Image size 2352x1568; color fundus image; 45-degree field of view: 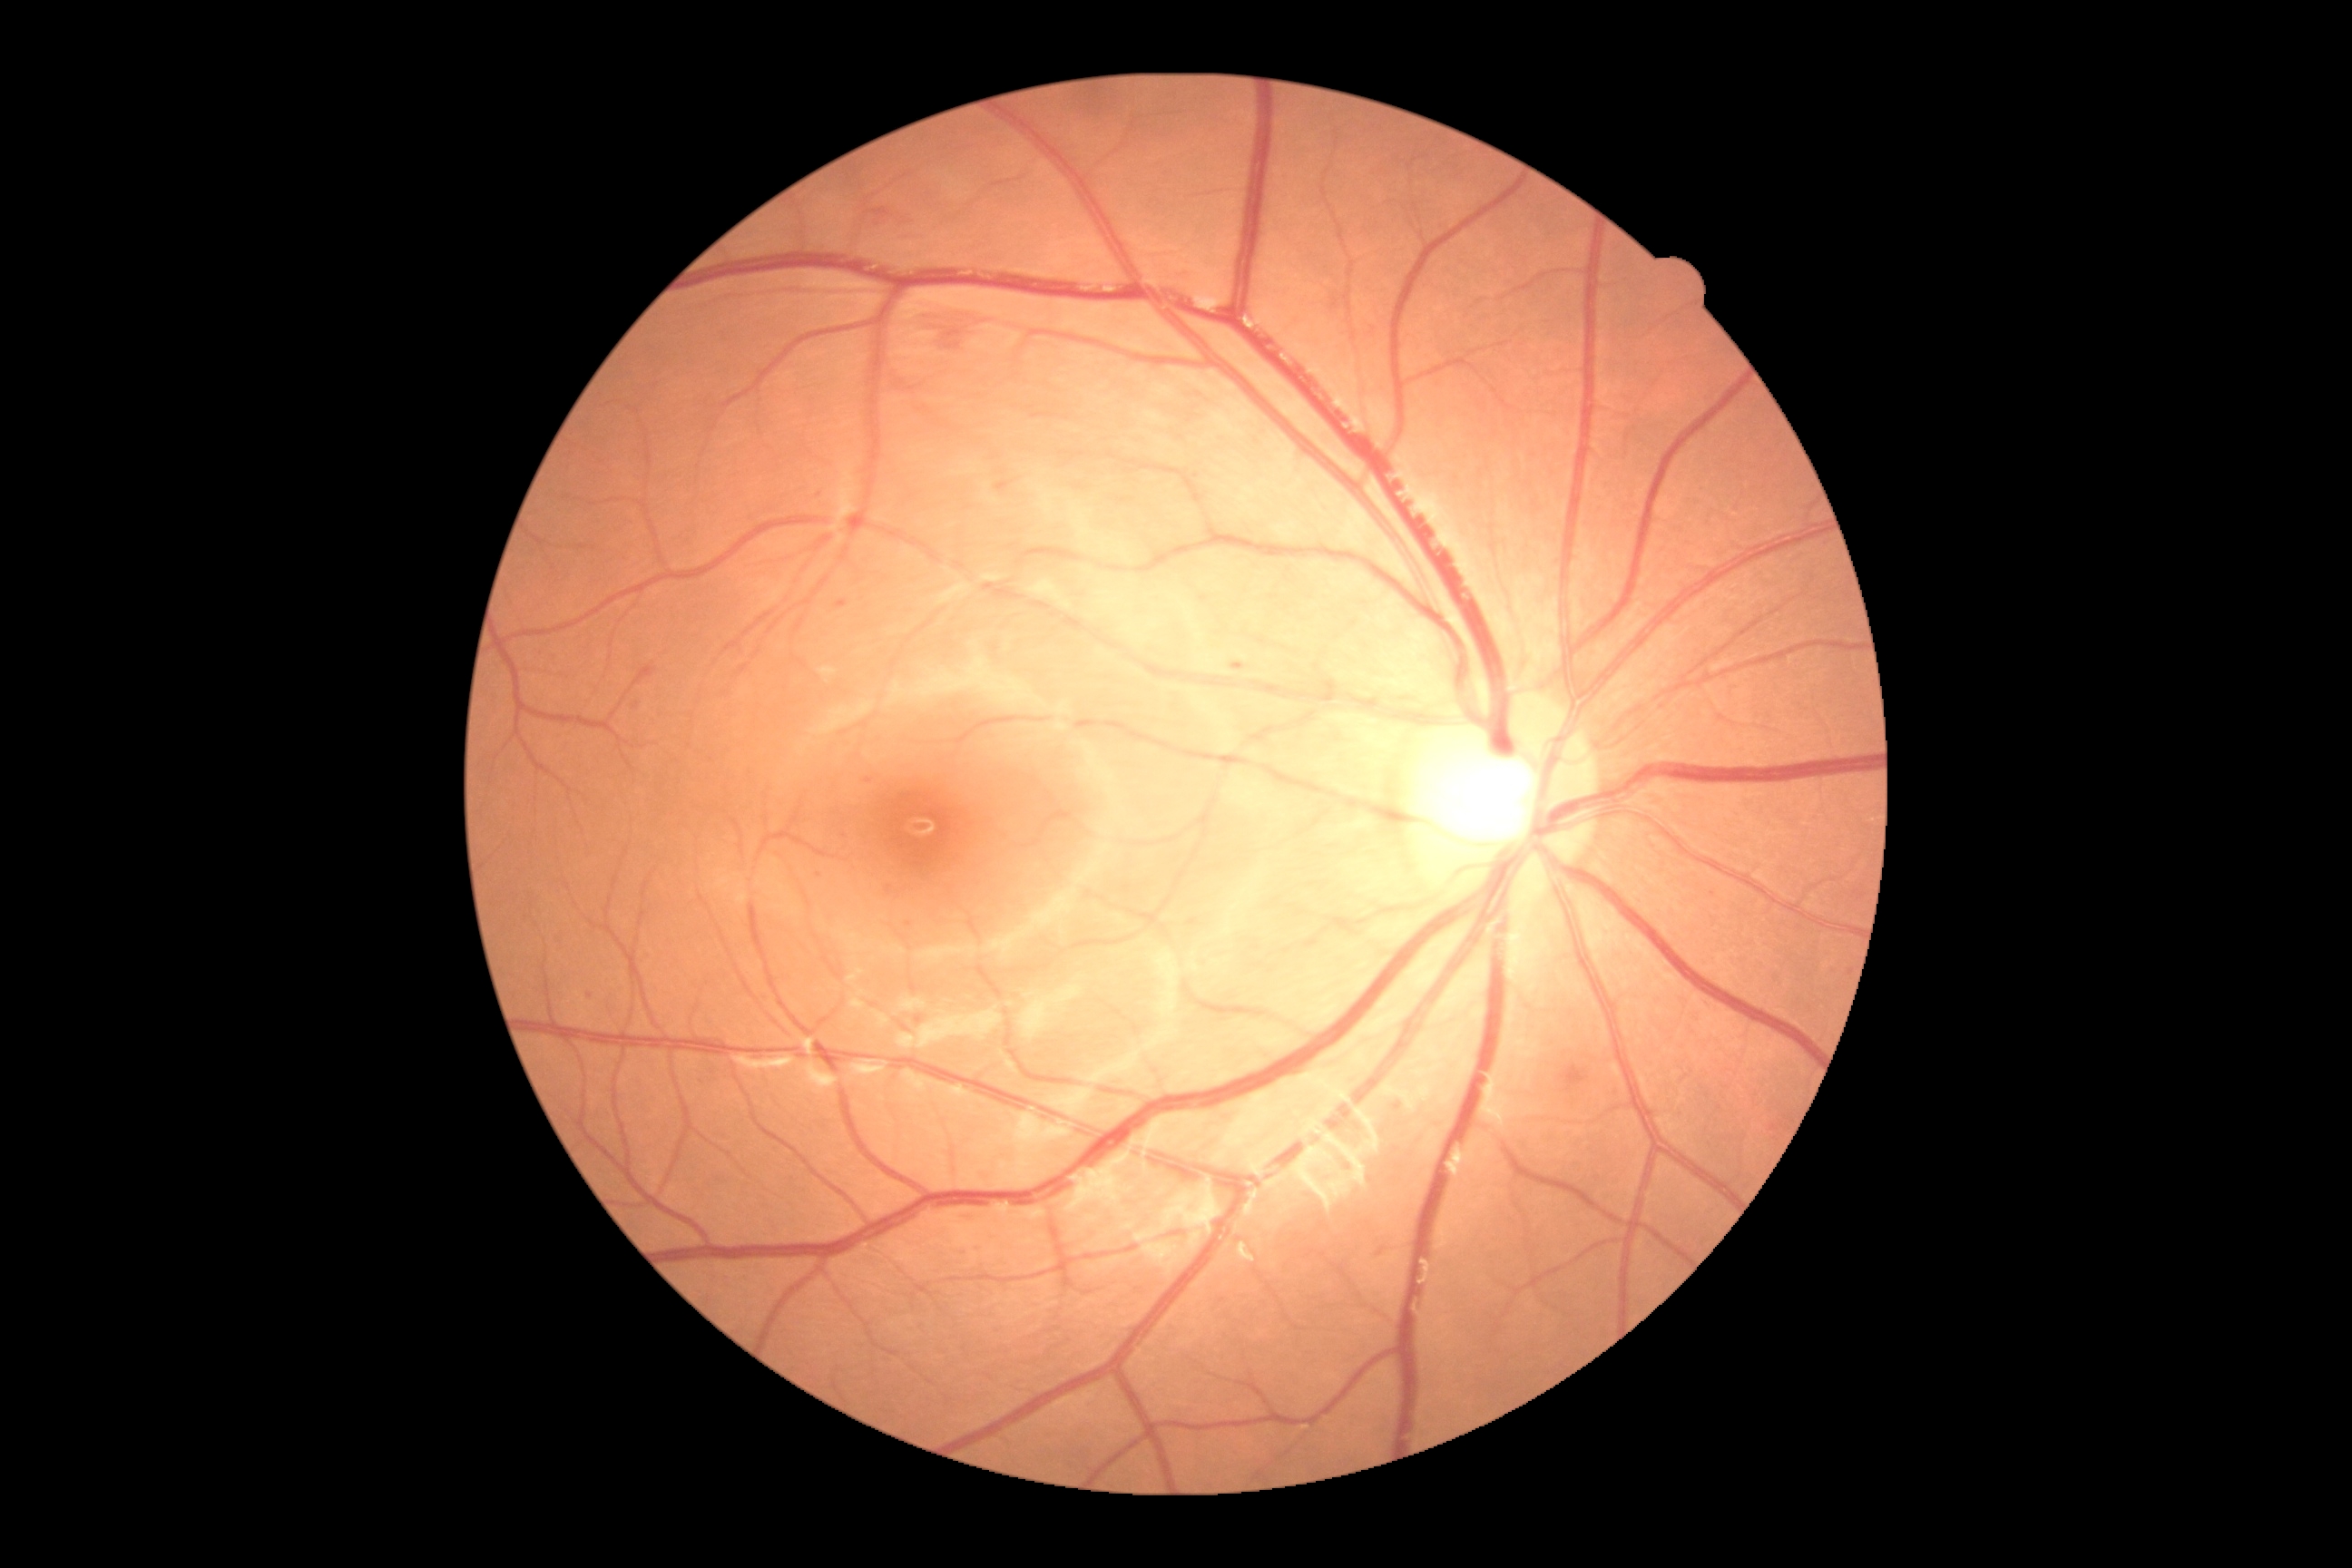 {
  "dr_grade": "2 — more than just microaneurysms but less than severe NPDR"
}